Pediatric wide-field fundus photograph · acquired on the Phoenix ICON
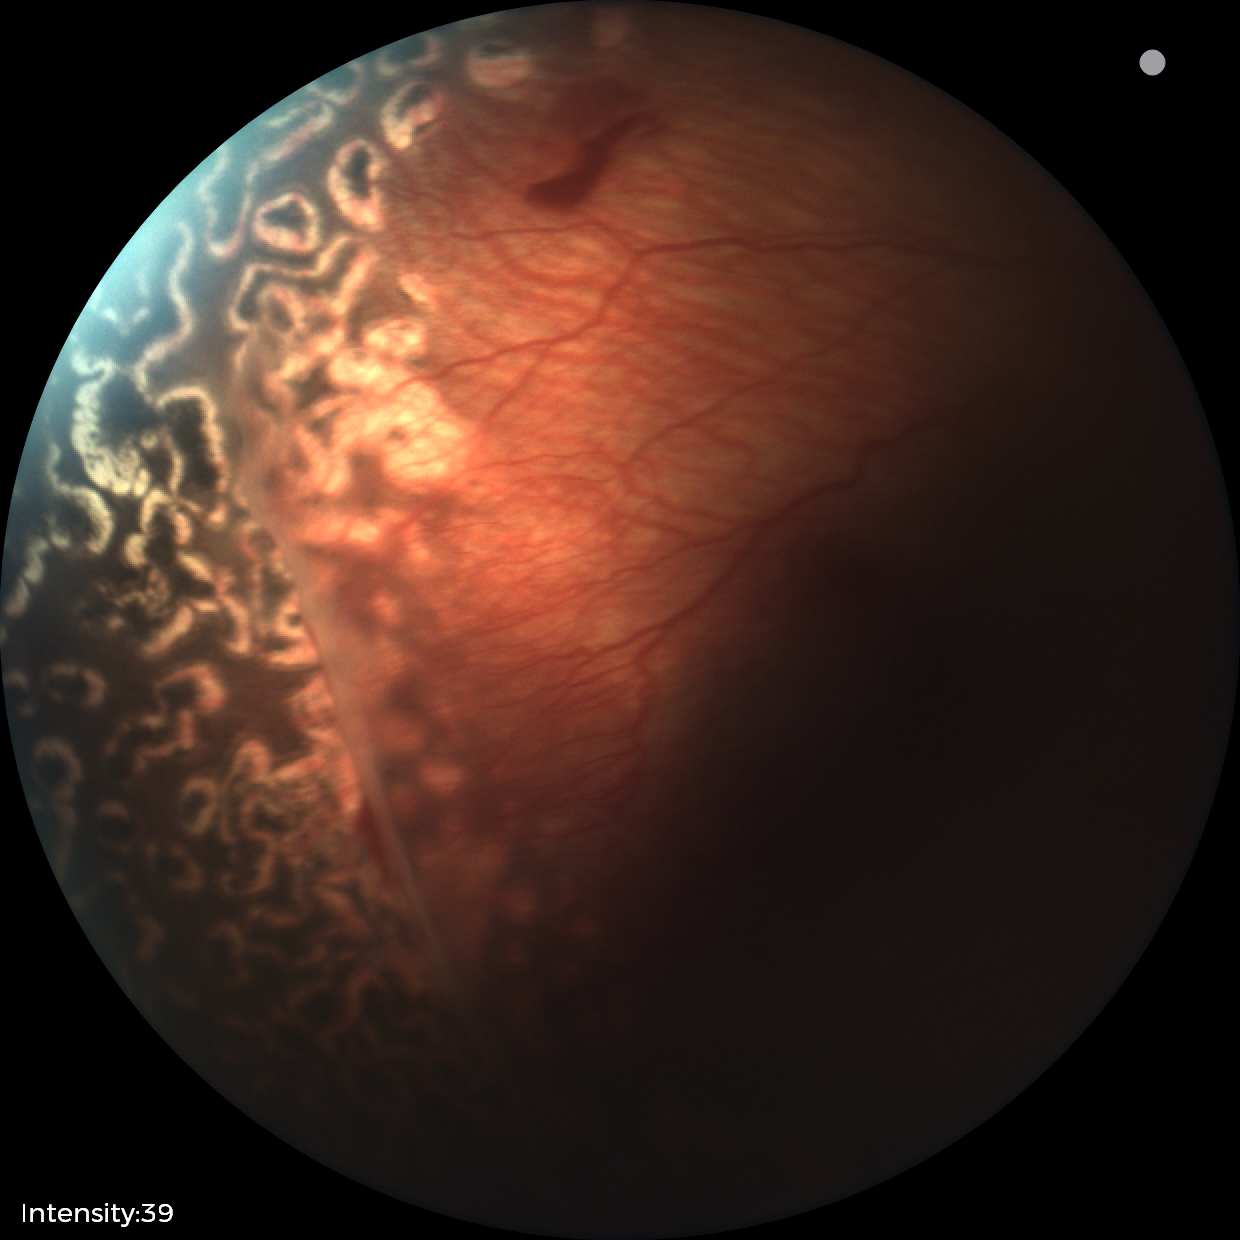

Assessment: status post retinopathy of prematurity.